Visual field mean defect (MD): 0.51 dB — 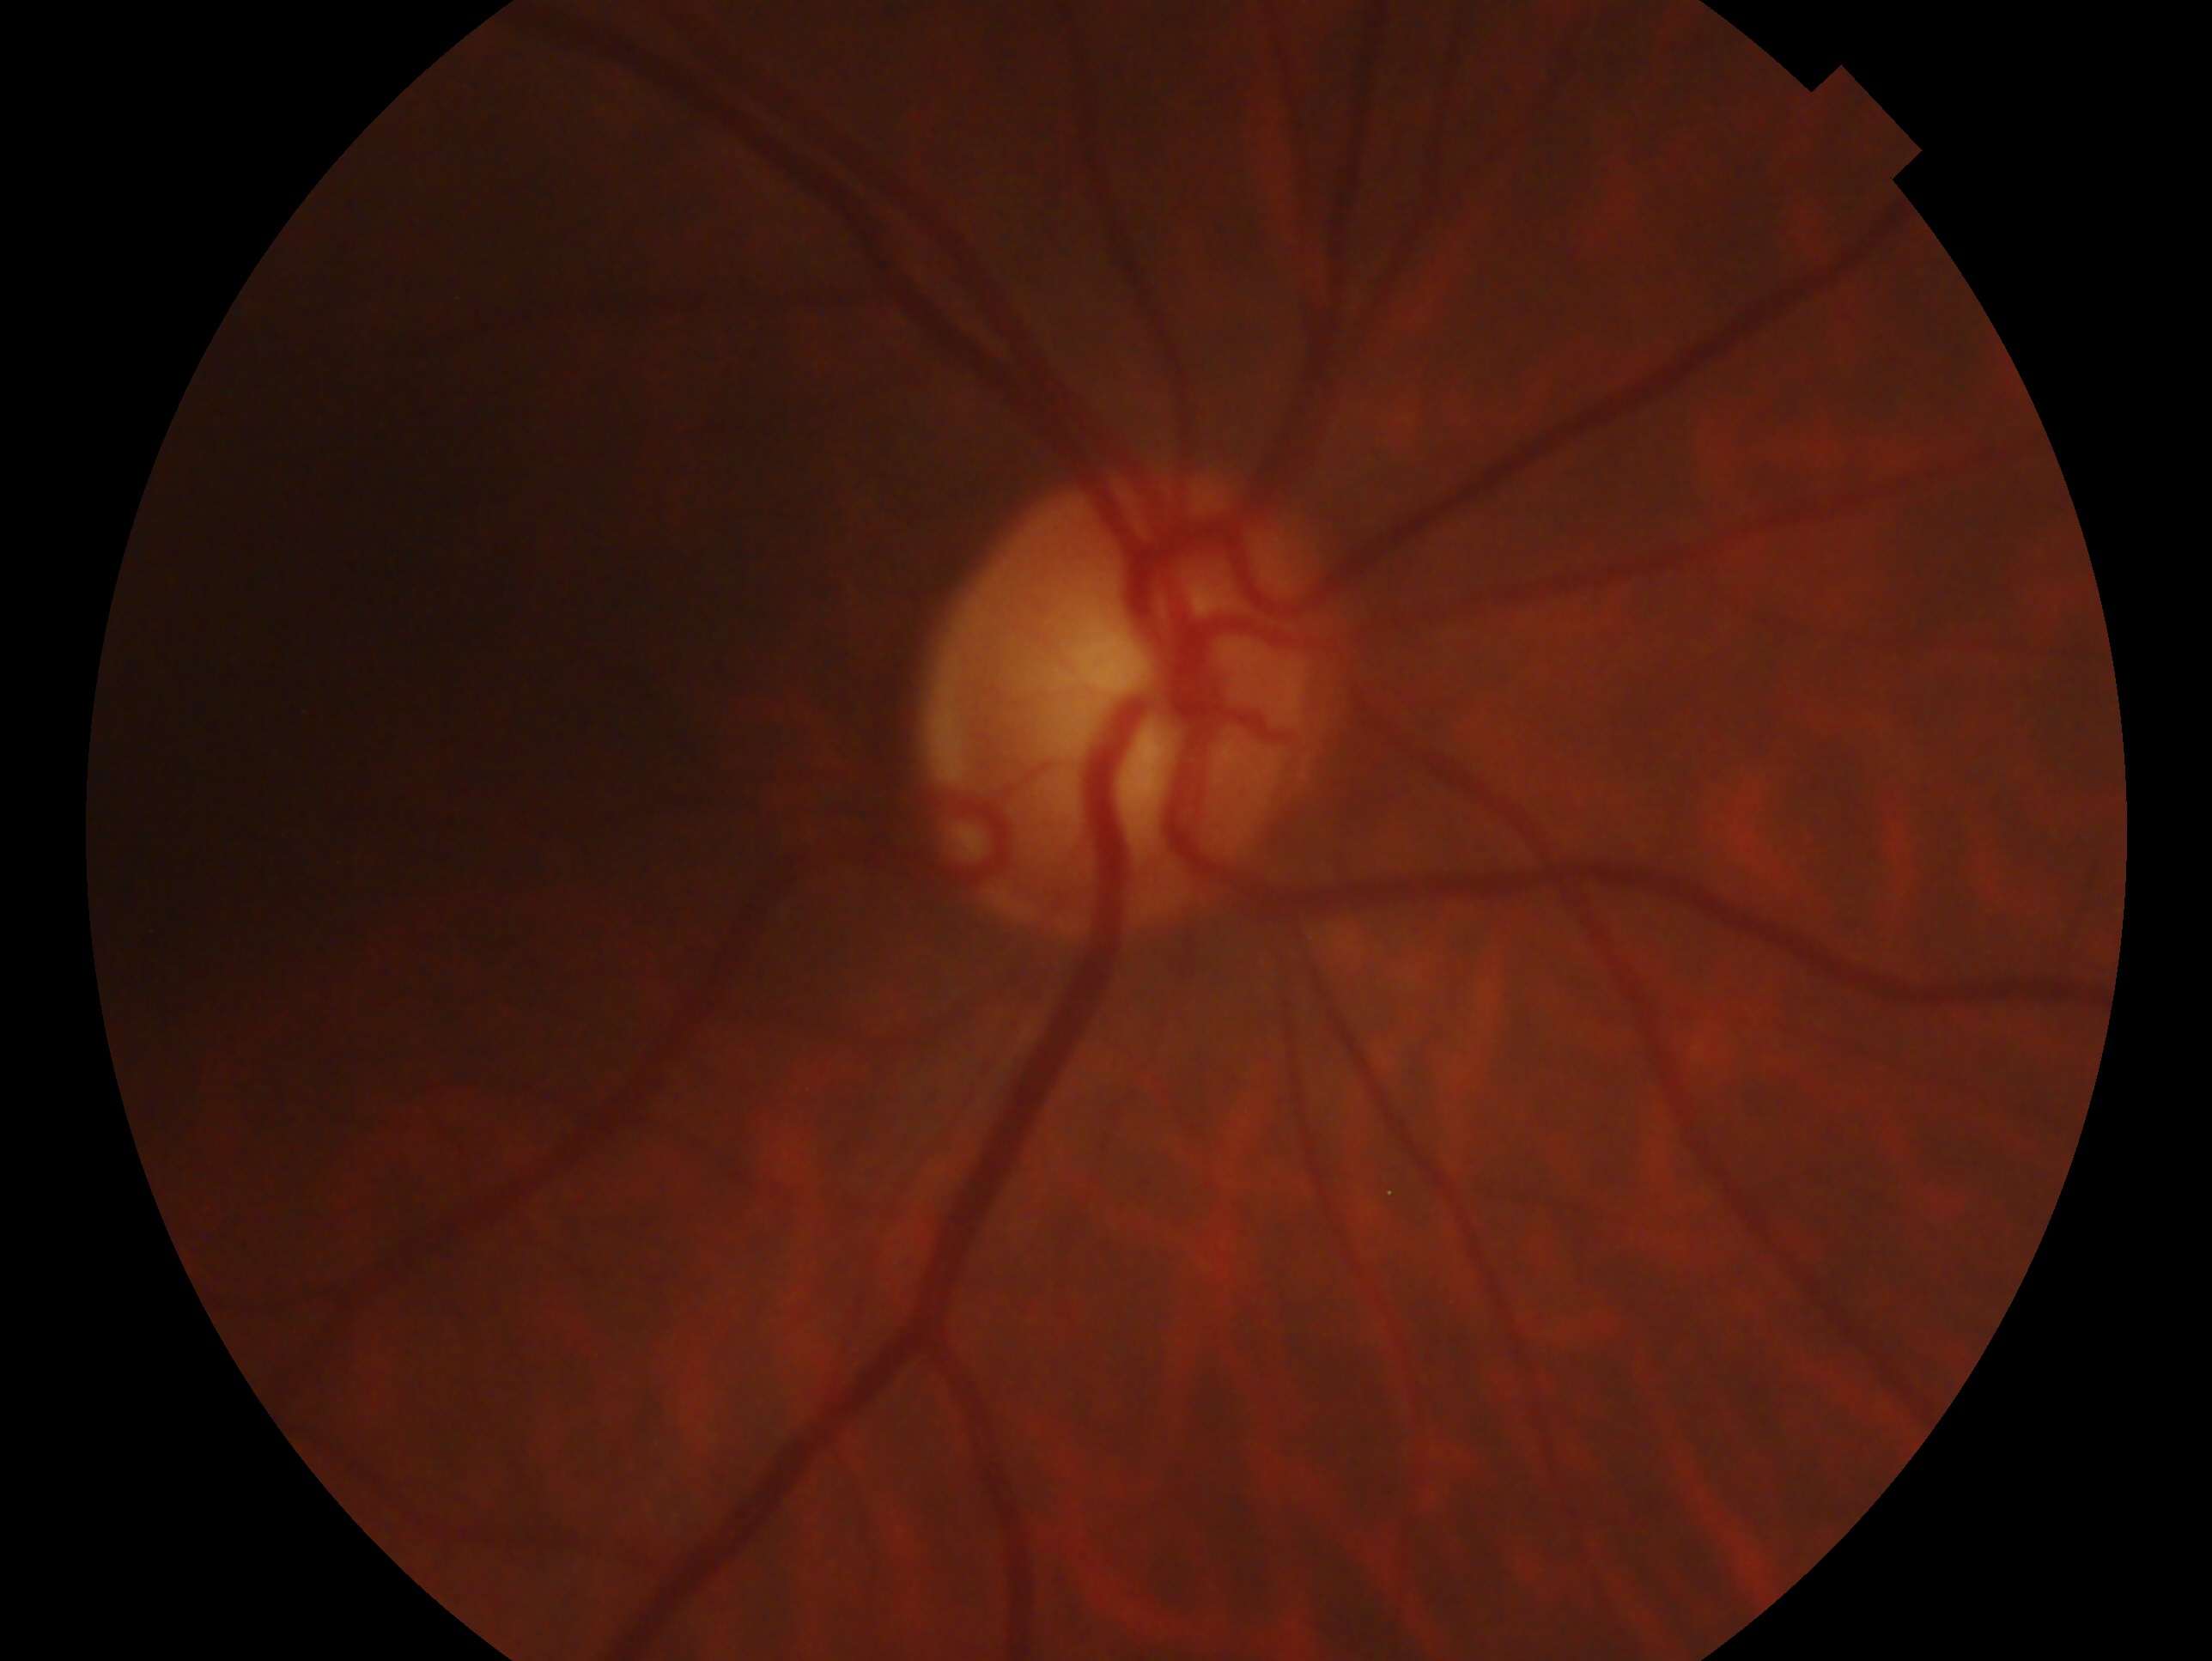

Glaucoma diagnosis: no evidence of glaucoma. Imaged eye: OD.